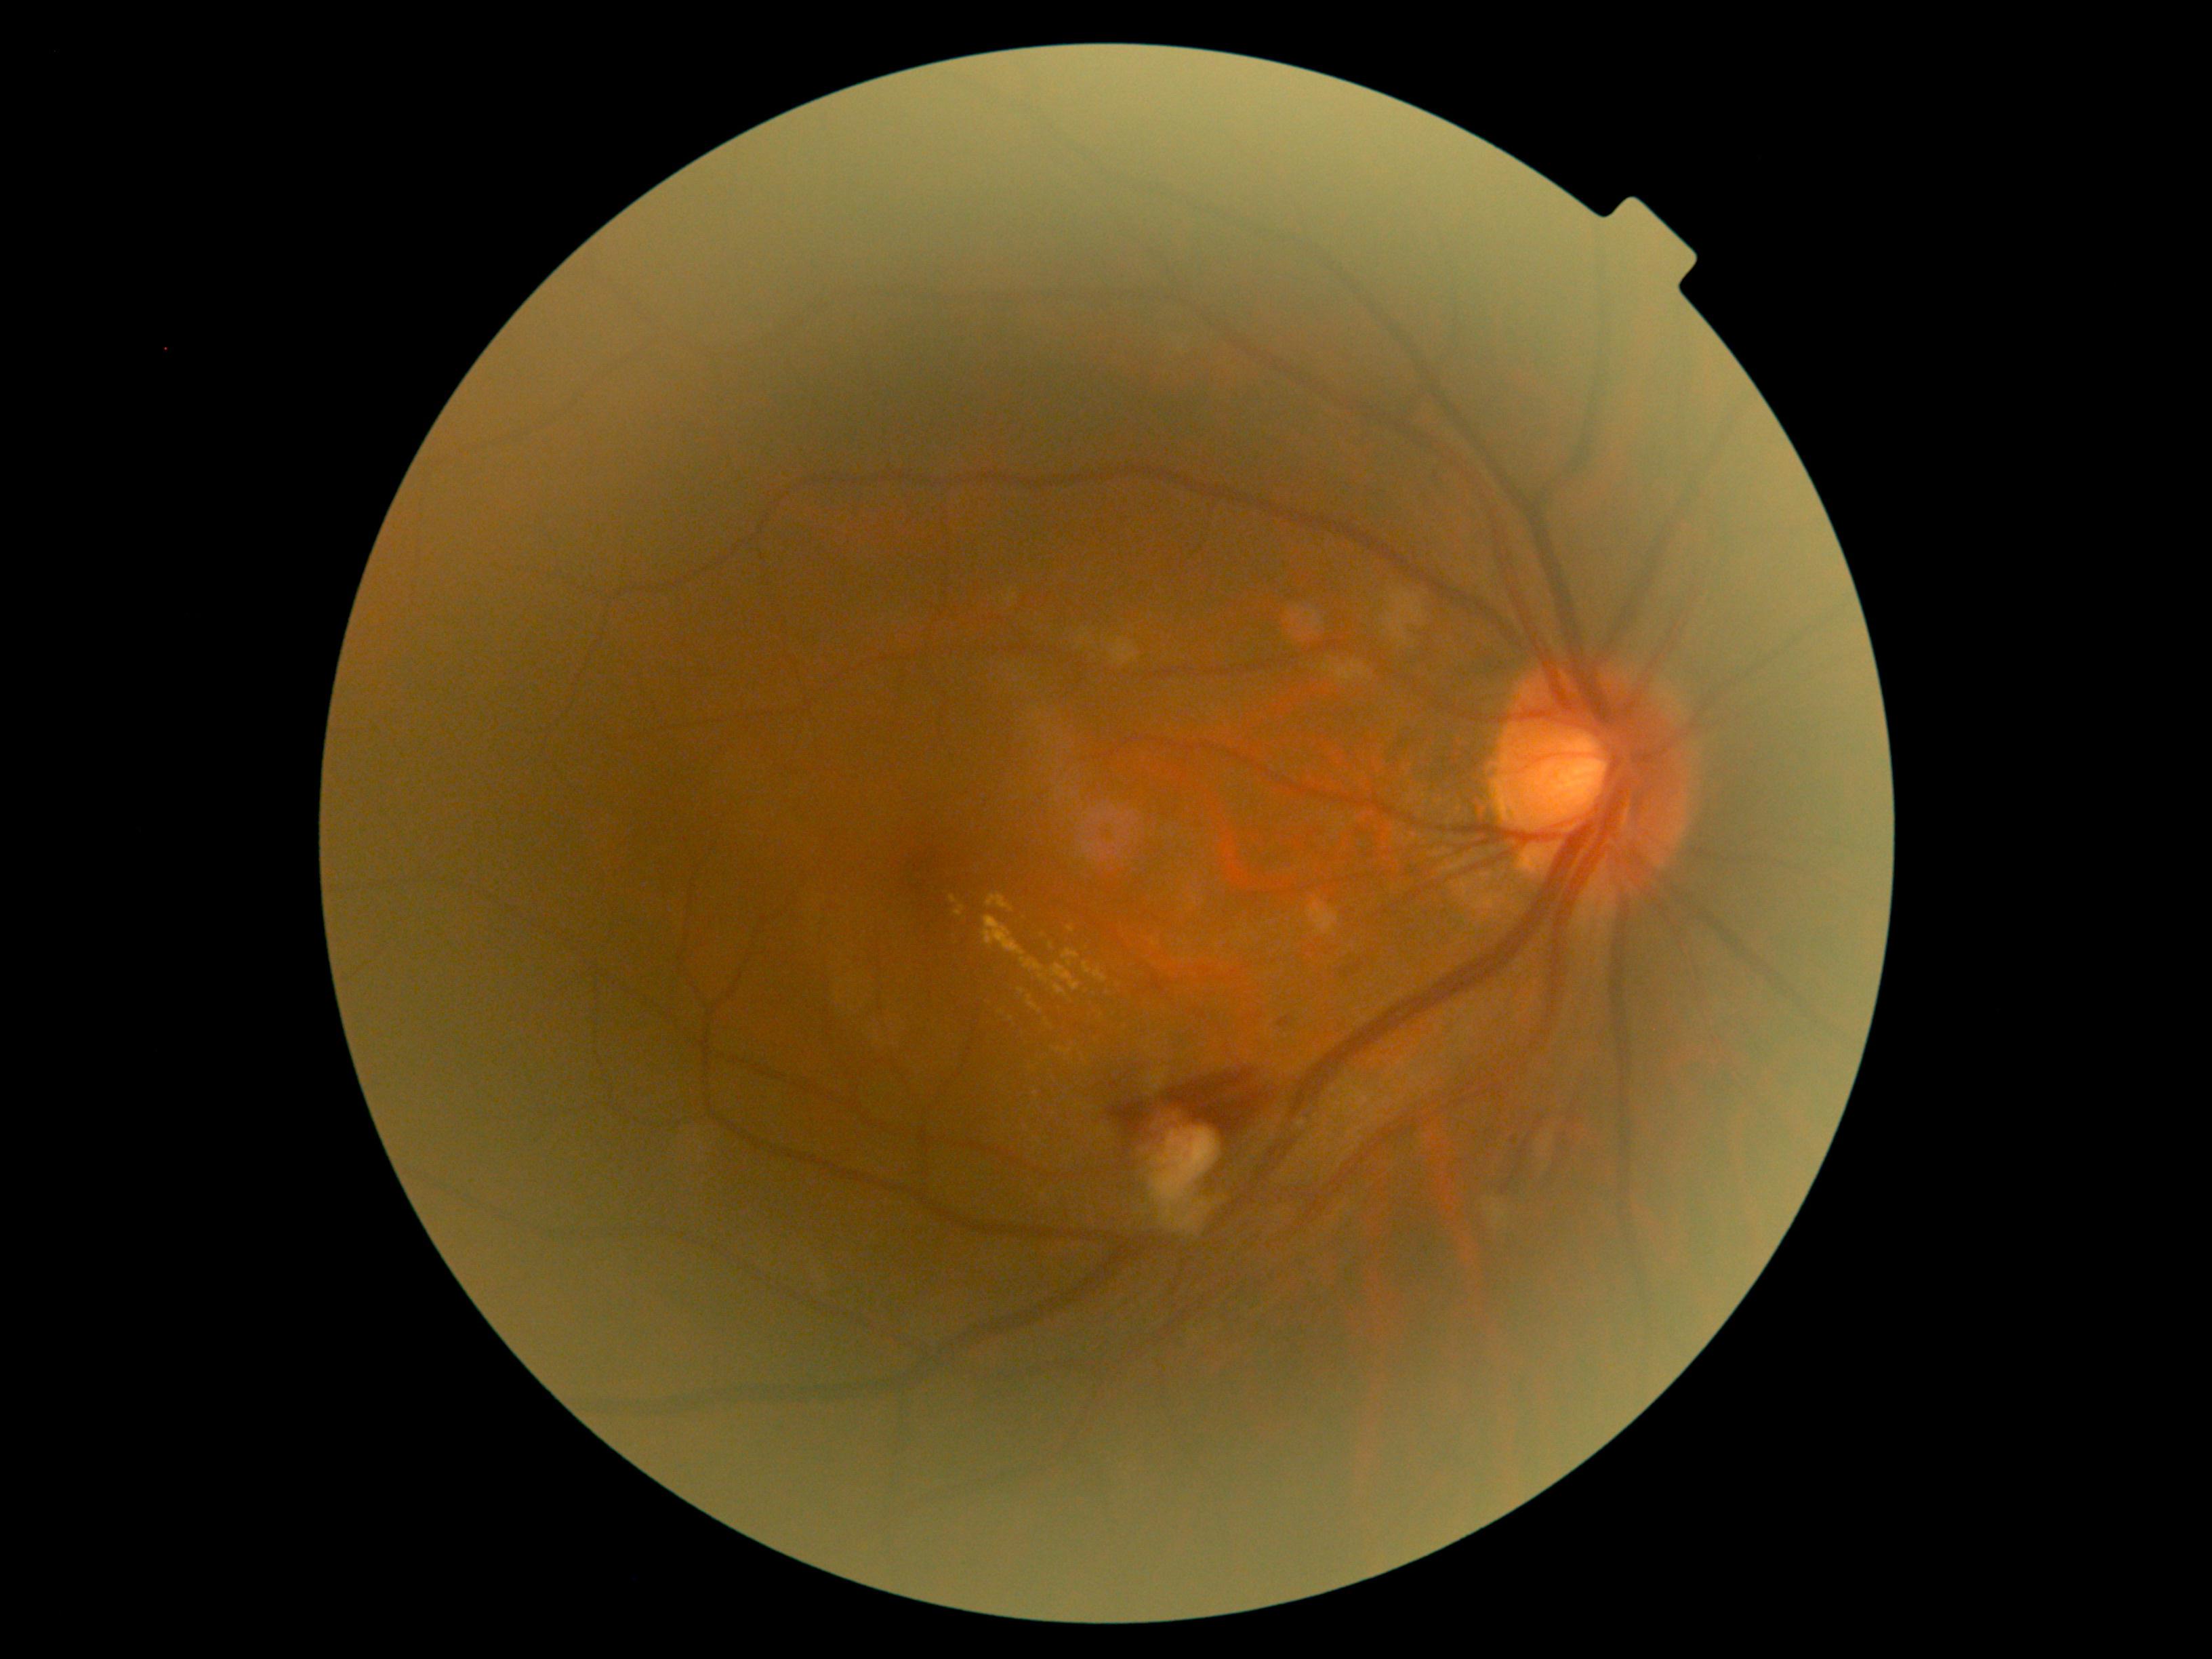 {"partial":true,"dr_grade":2,"dr_grade_name":"moderate NPDR","lesions":{"ma":null,"ex":[[1055,1048,1073,1057],[1050,963,1081,991],[1027,996,1042,1012],[1084,962,1108,982],[982,916,1048,982],[1054,985,1066,996],[1066,926,1074,933],[949,895,958,903],[1062,948,1081,967],[954,906,964,916],[986,894,1015,913]],"ex_small_approx":[[1022,991],[1001,1012],[1052,945],[1036,1095],[1011,1018],[1049,1025]],"he":[[1279,1016,1290,1028],[1111,1082,1118,1090],[1340,949,1379,979],[1161,1069,1269,1138],[1107,1099,1160,1143]],"he_small_approx":[[1514,1139]],"se":[[1336,662,1370,682],[1535,1113,1562,1176],[1006,590,1016,604],[1307,901,1340,936],[1486,1204,1509,1225],[1138,1099,1225,1230],[1112,639,1135,665],[1322,665,1333,673],[1378,577,1441,654]],"se_small_approx":[[1491,1200],[1084,637],[1086,629]]}}